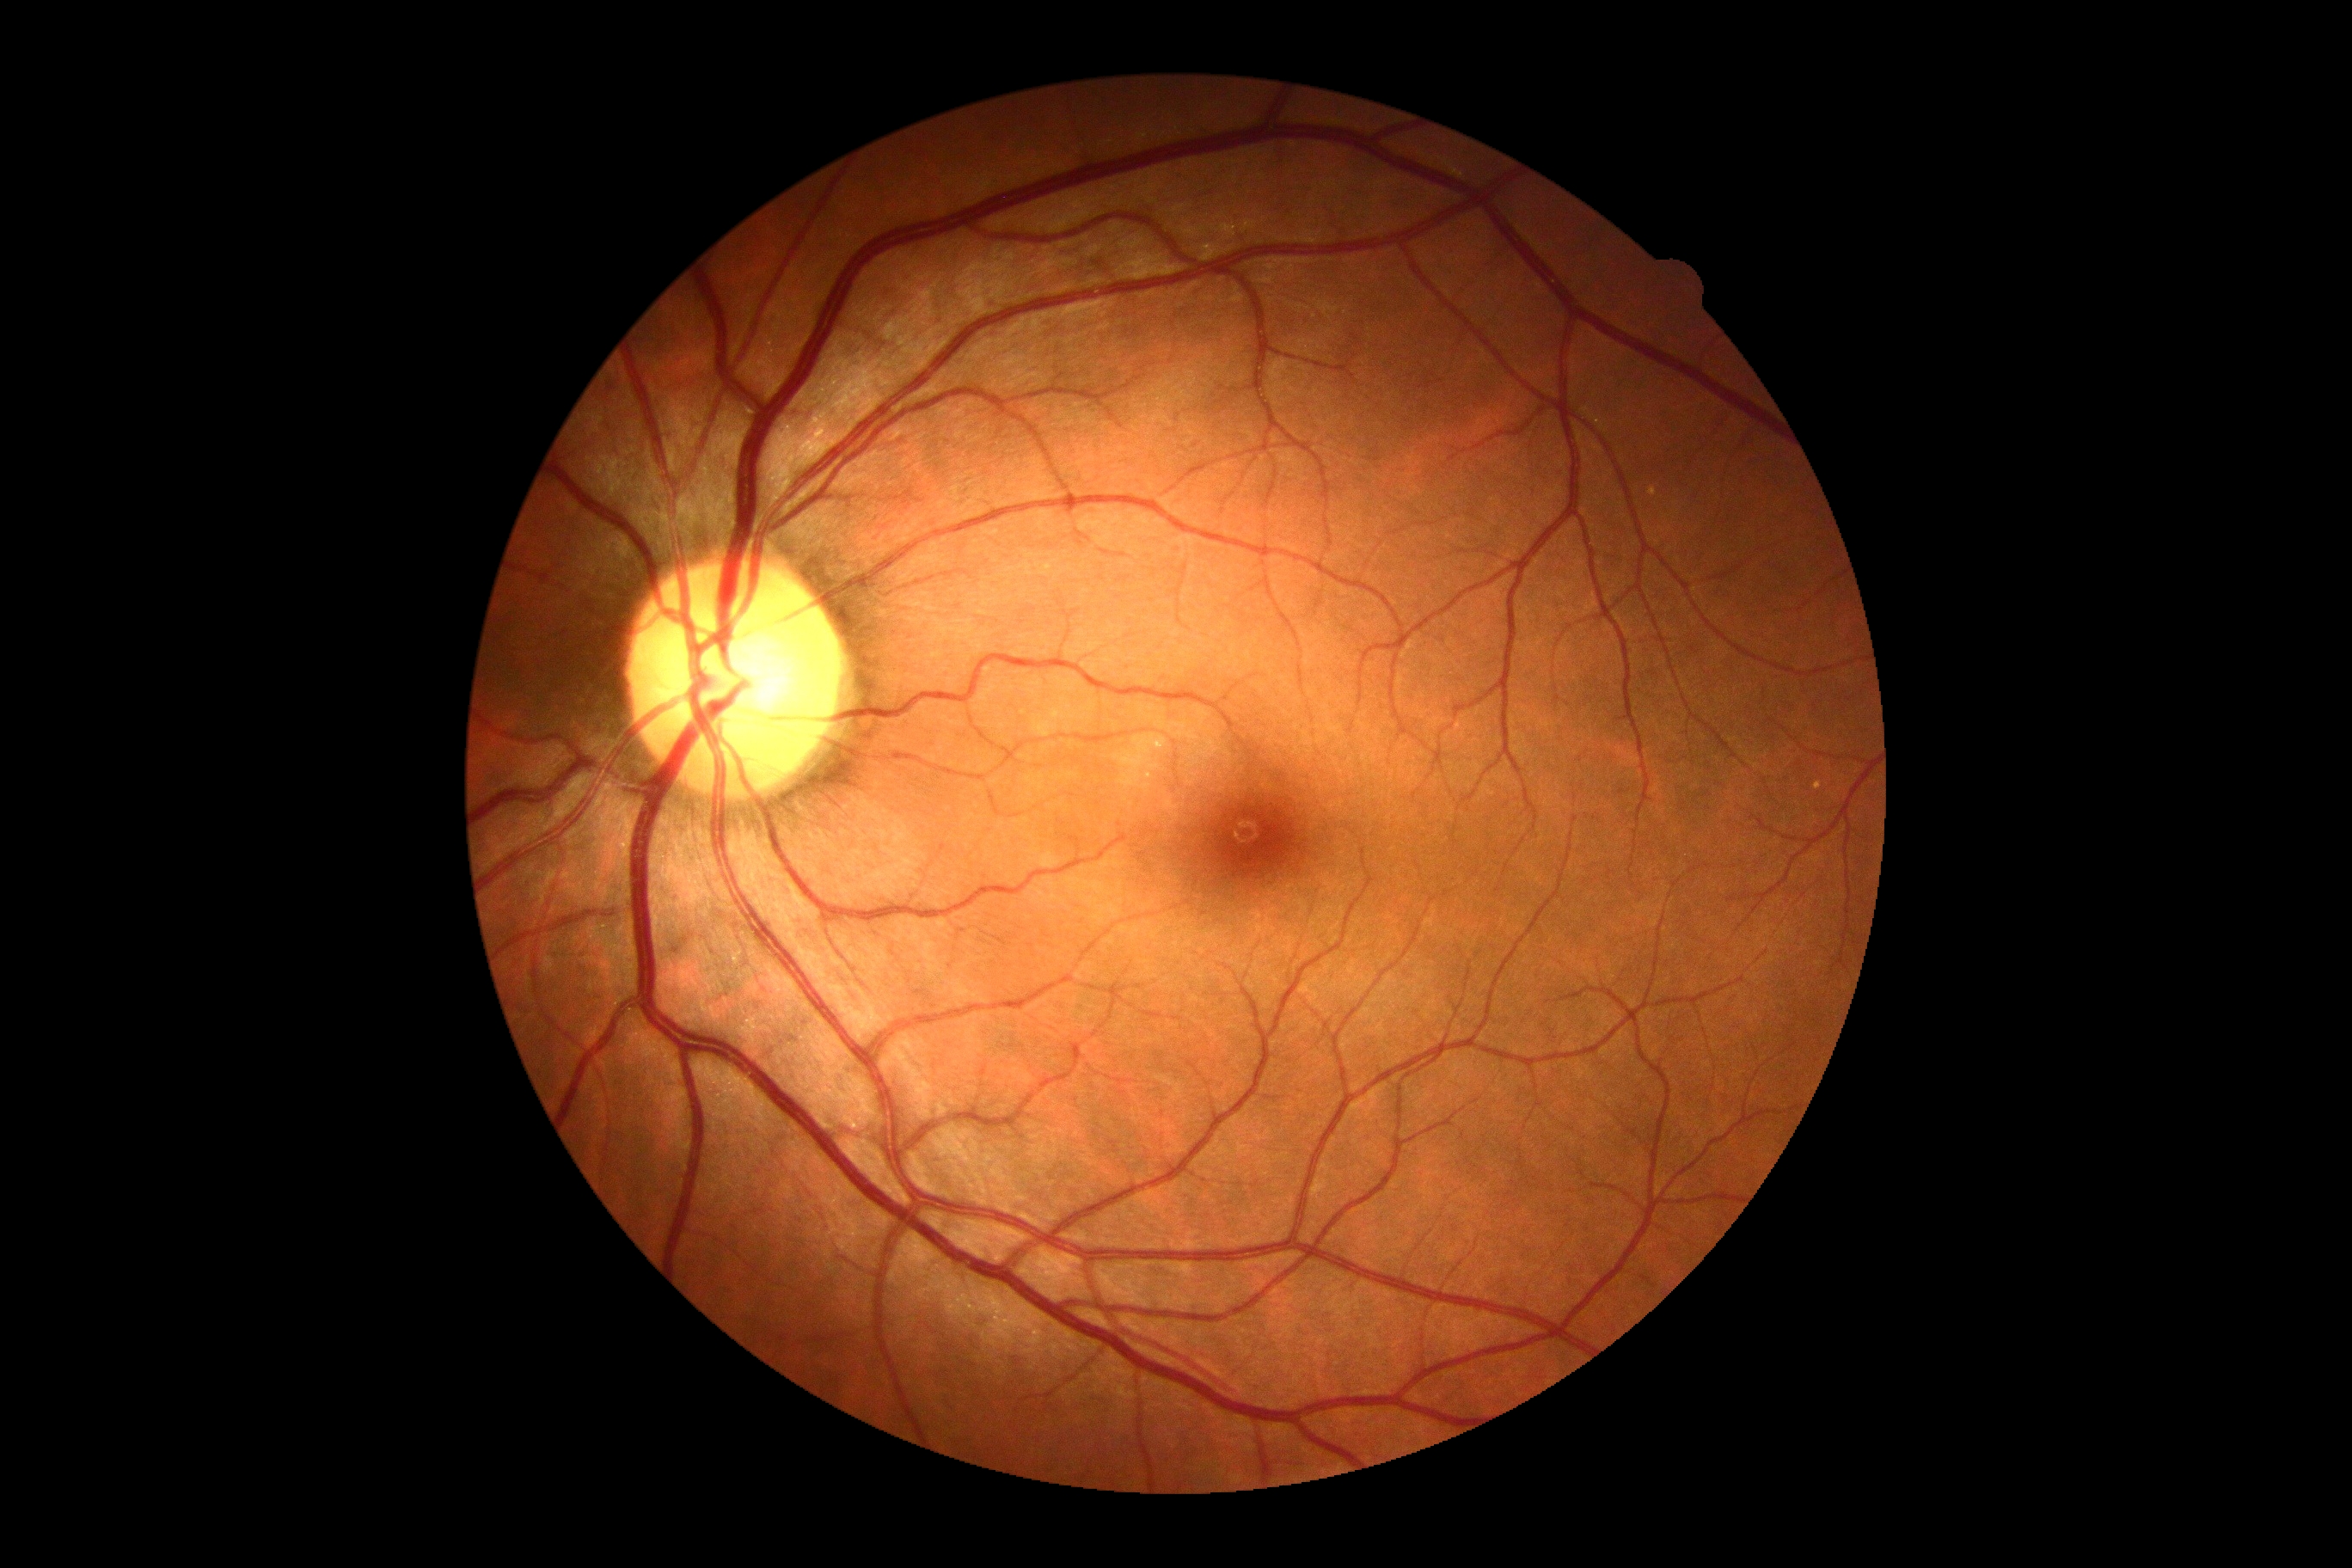 dr_grade: no apparent diabetic retinopathy (grade 0)